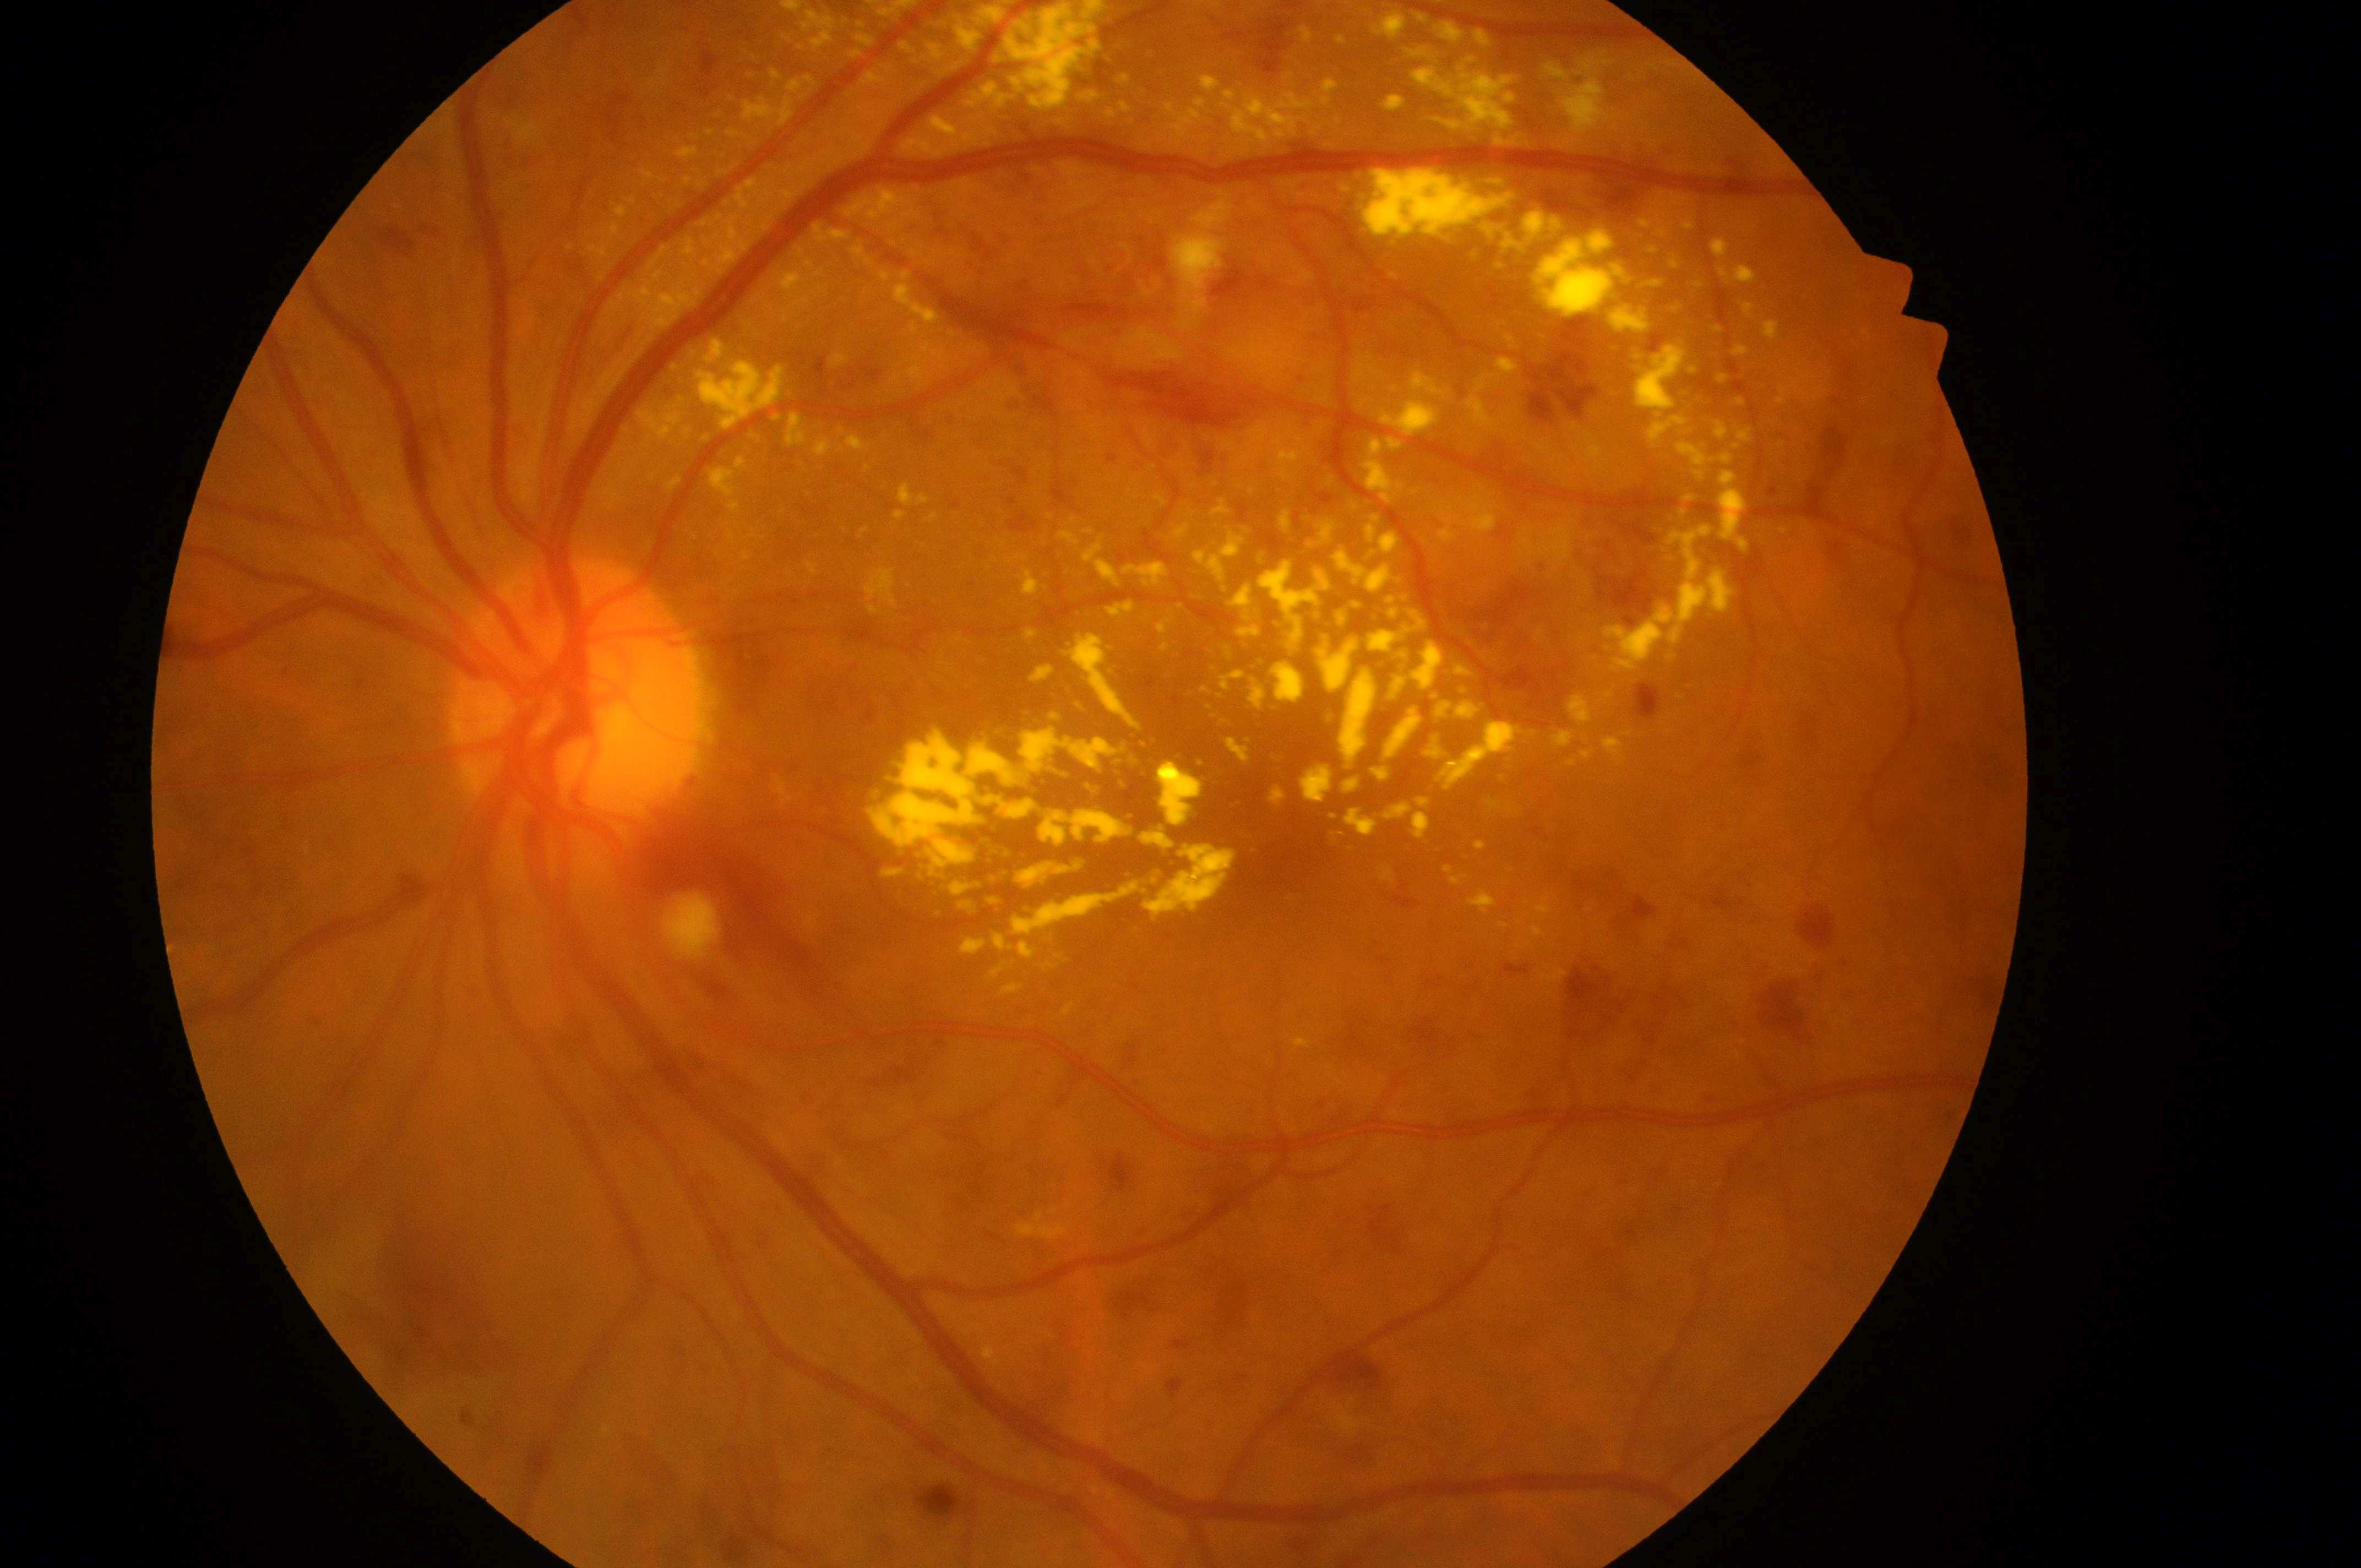

laterality: left; DR grade: 3 (severe NPDR) — more than 20 intraretinal hemorrhages in each of 4 quadrants, definite venous beading in 2 or more quadrants, or prominent intraretinal microvascular abnormalities in 1 or more quadrants, with no signs of proliferative retinopathy; fovea: x=1289, y=851; DME: grade 2 (high risk) — hard exudates within one disc diameter of the macula center; optic disc center: x=573, y=713.